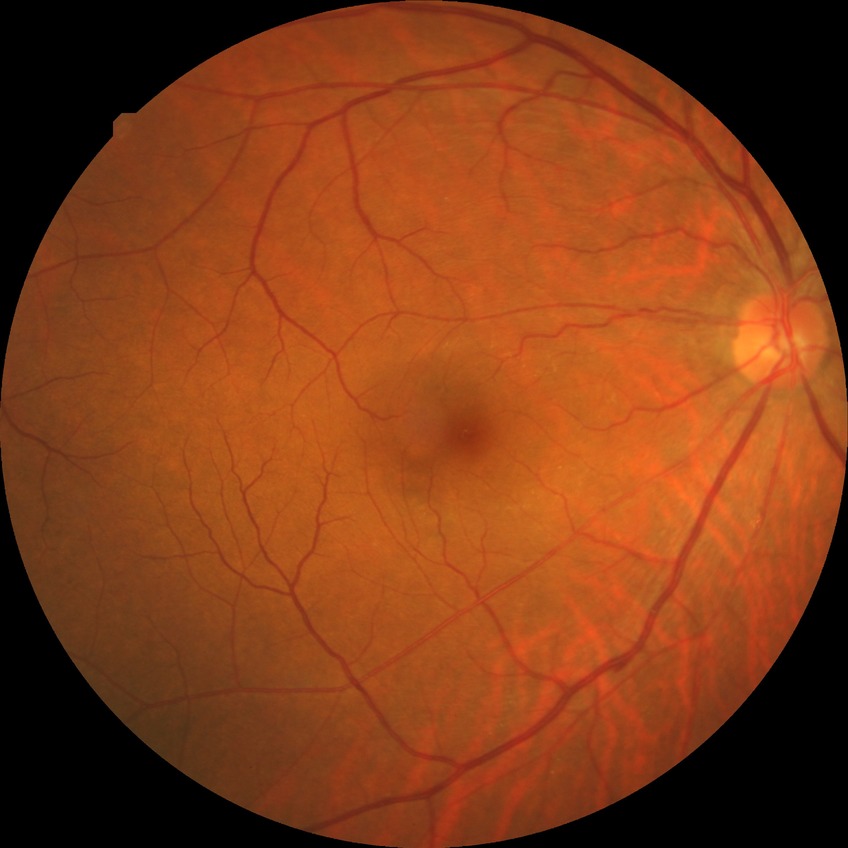
Retinopathy stage: simple diabetic retinopathy.